Ultra-widefield fundus photograph. 200° field of view.
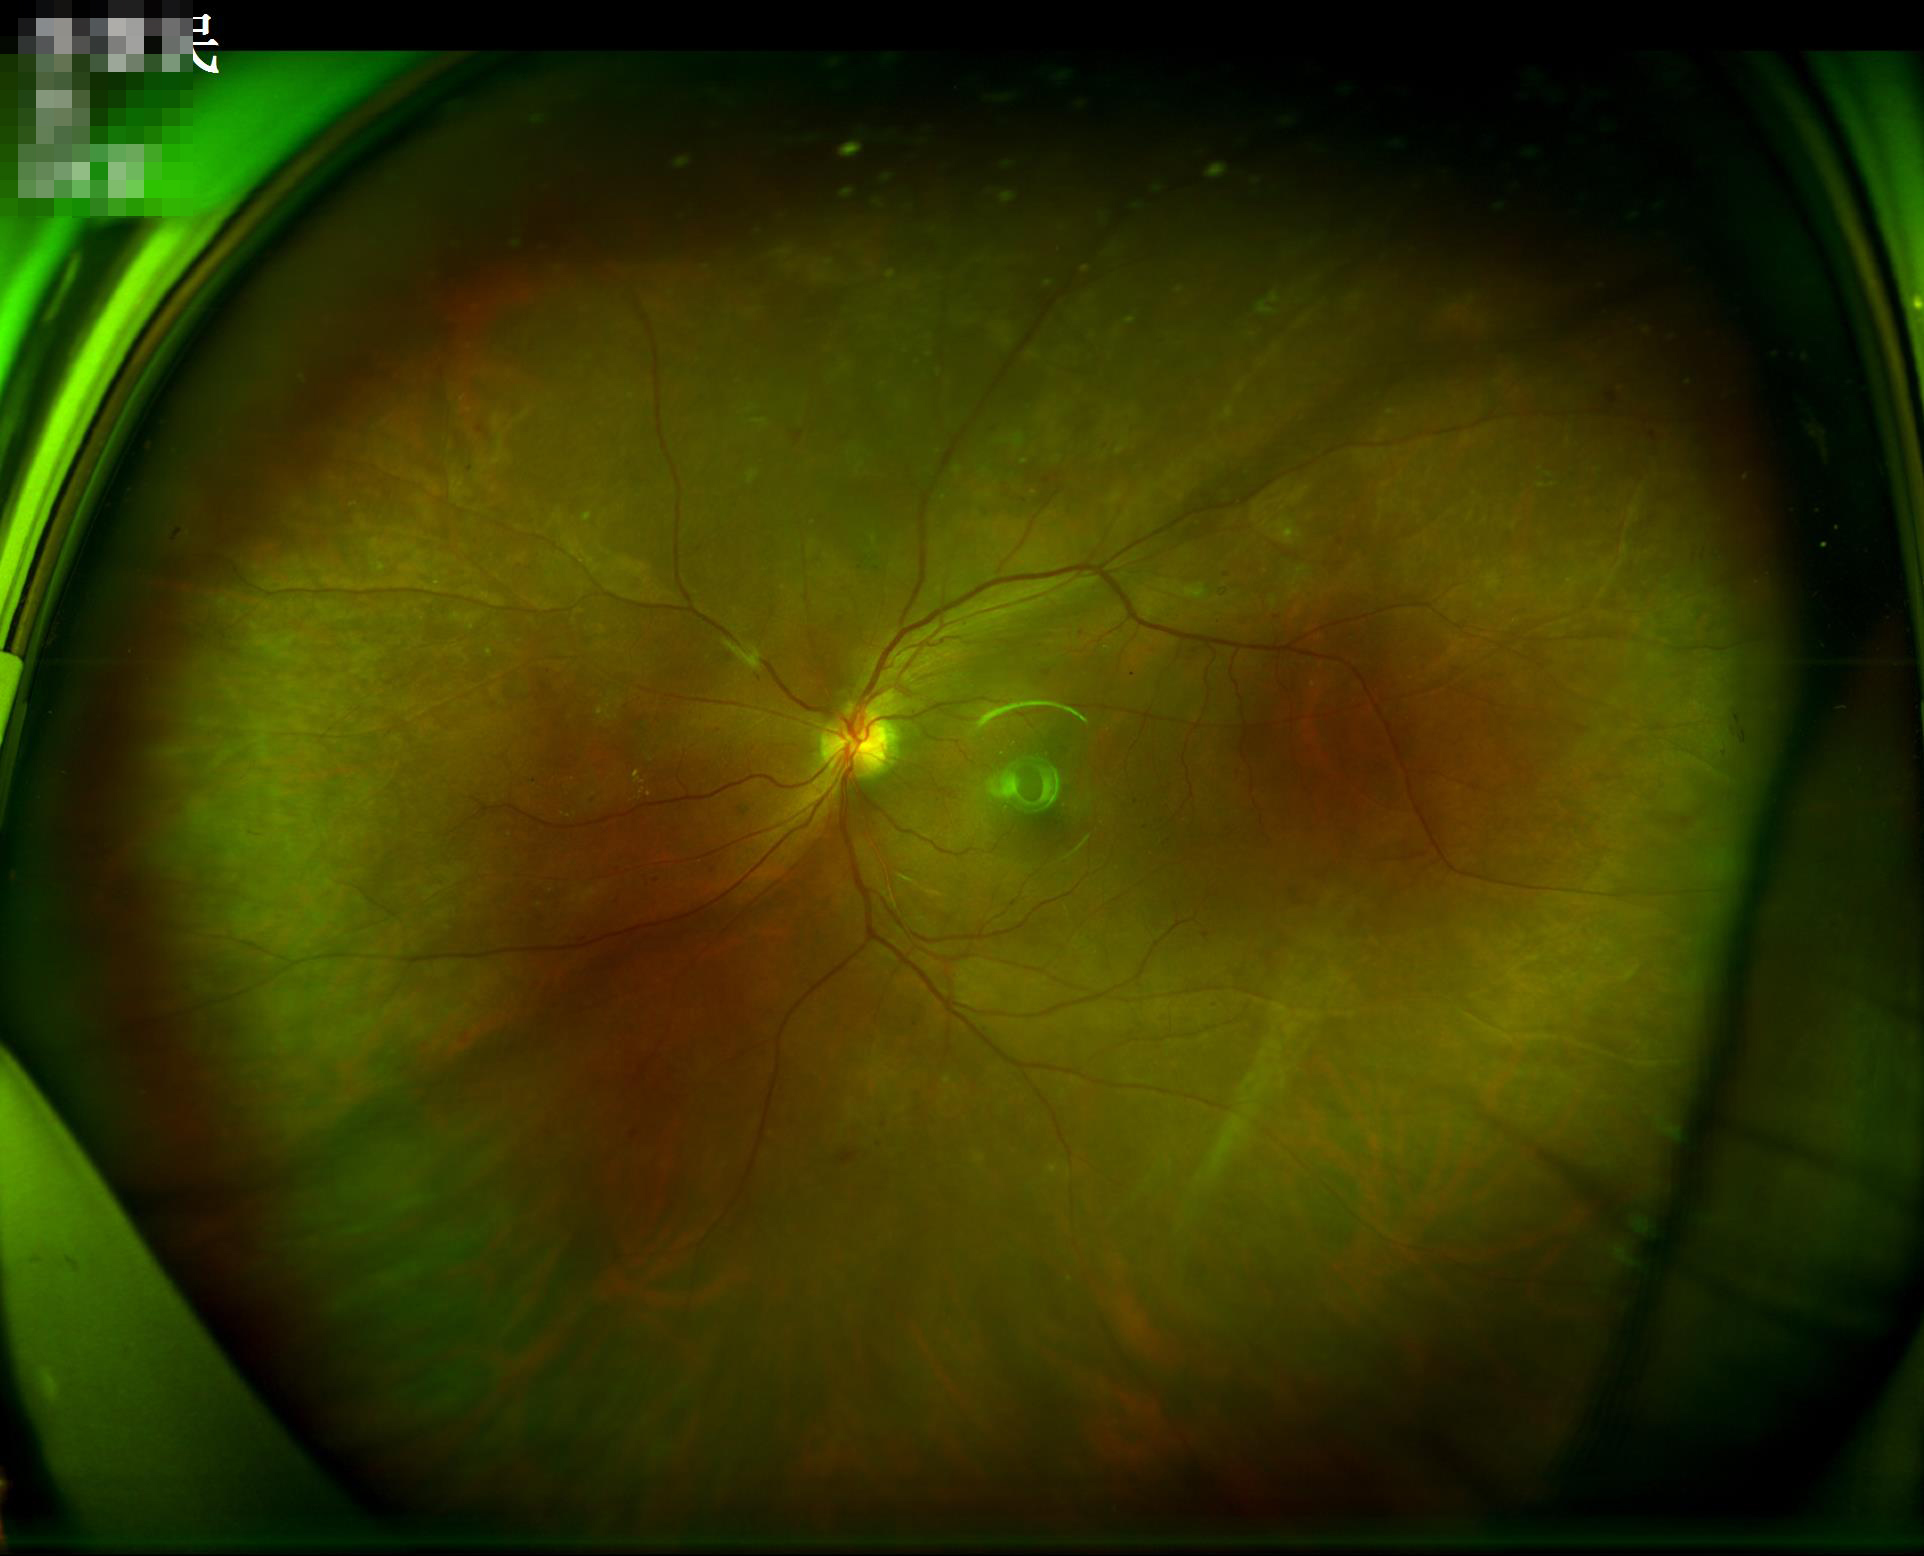 Quality assessment: overall: good and suitable for diagnostic use | contrast: wide intensity range, structures distinguishable.